Pachymetry 487 µm. Centered on the optic disc. Captured on a Topcon TRC-NW400 fundus camera. Intraocular pressure (IOP) 16 mmHg by non-contact tonometry
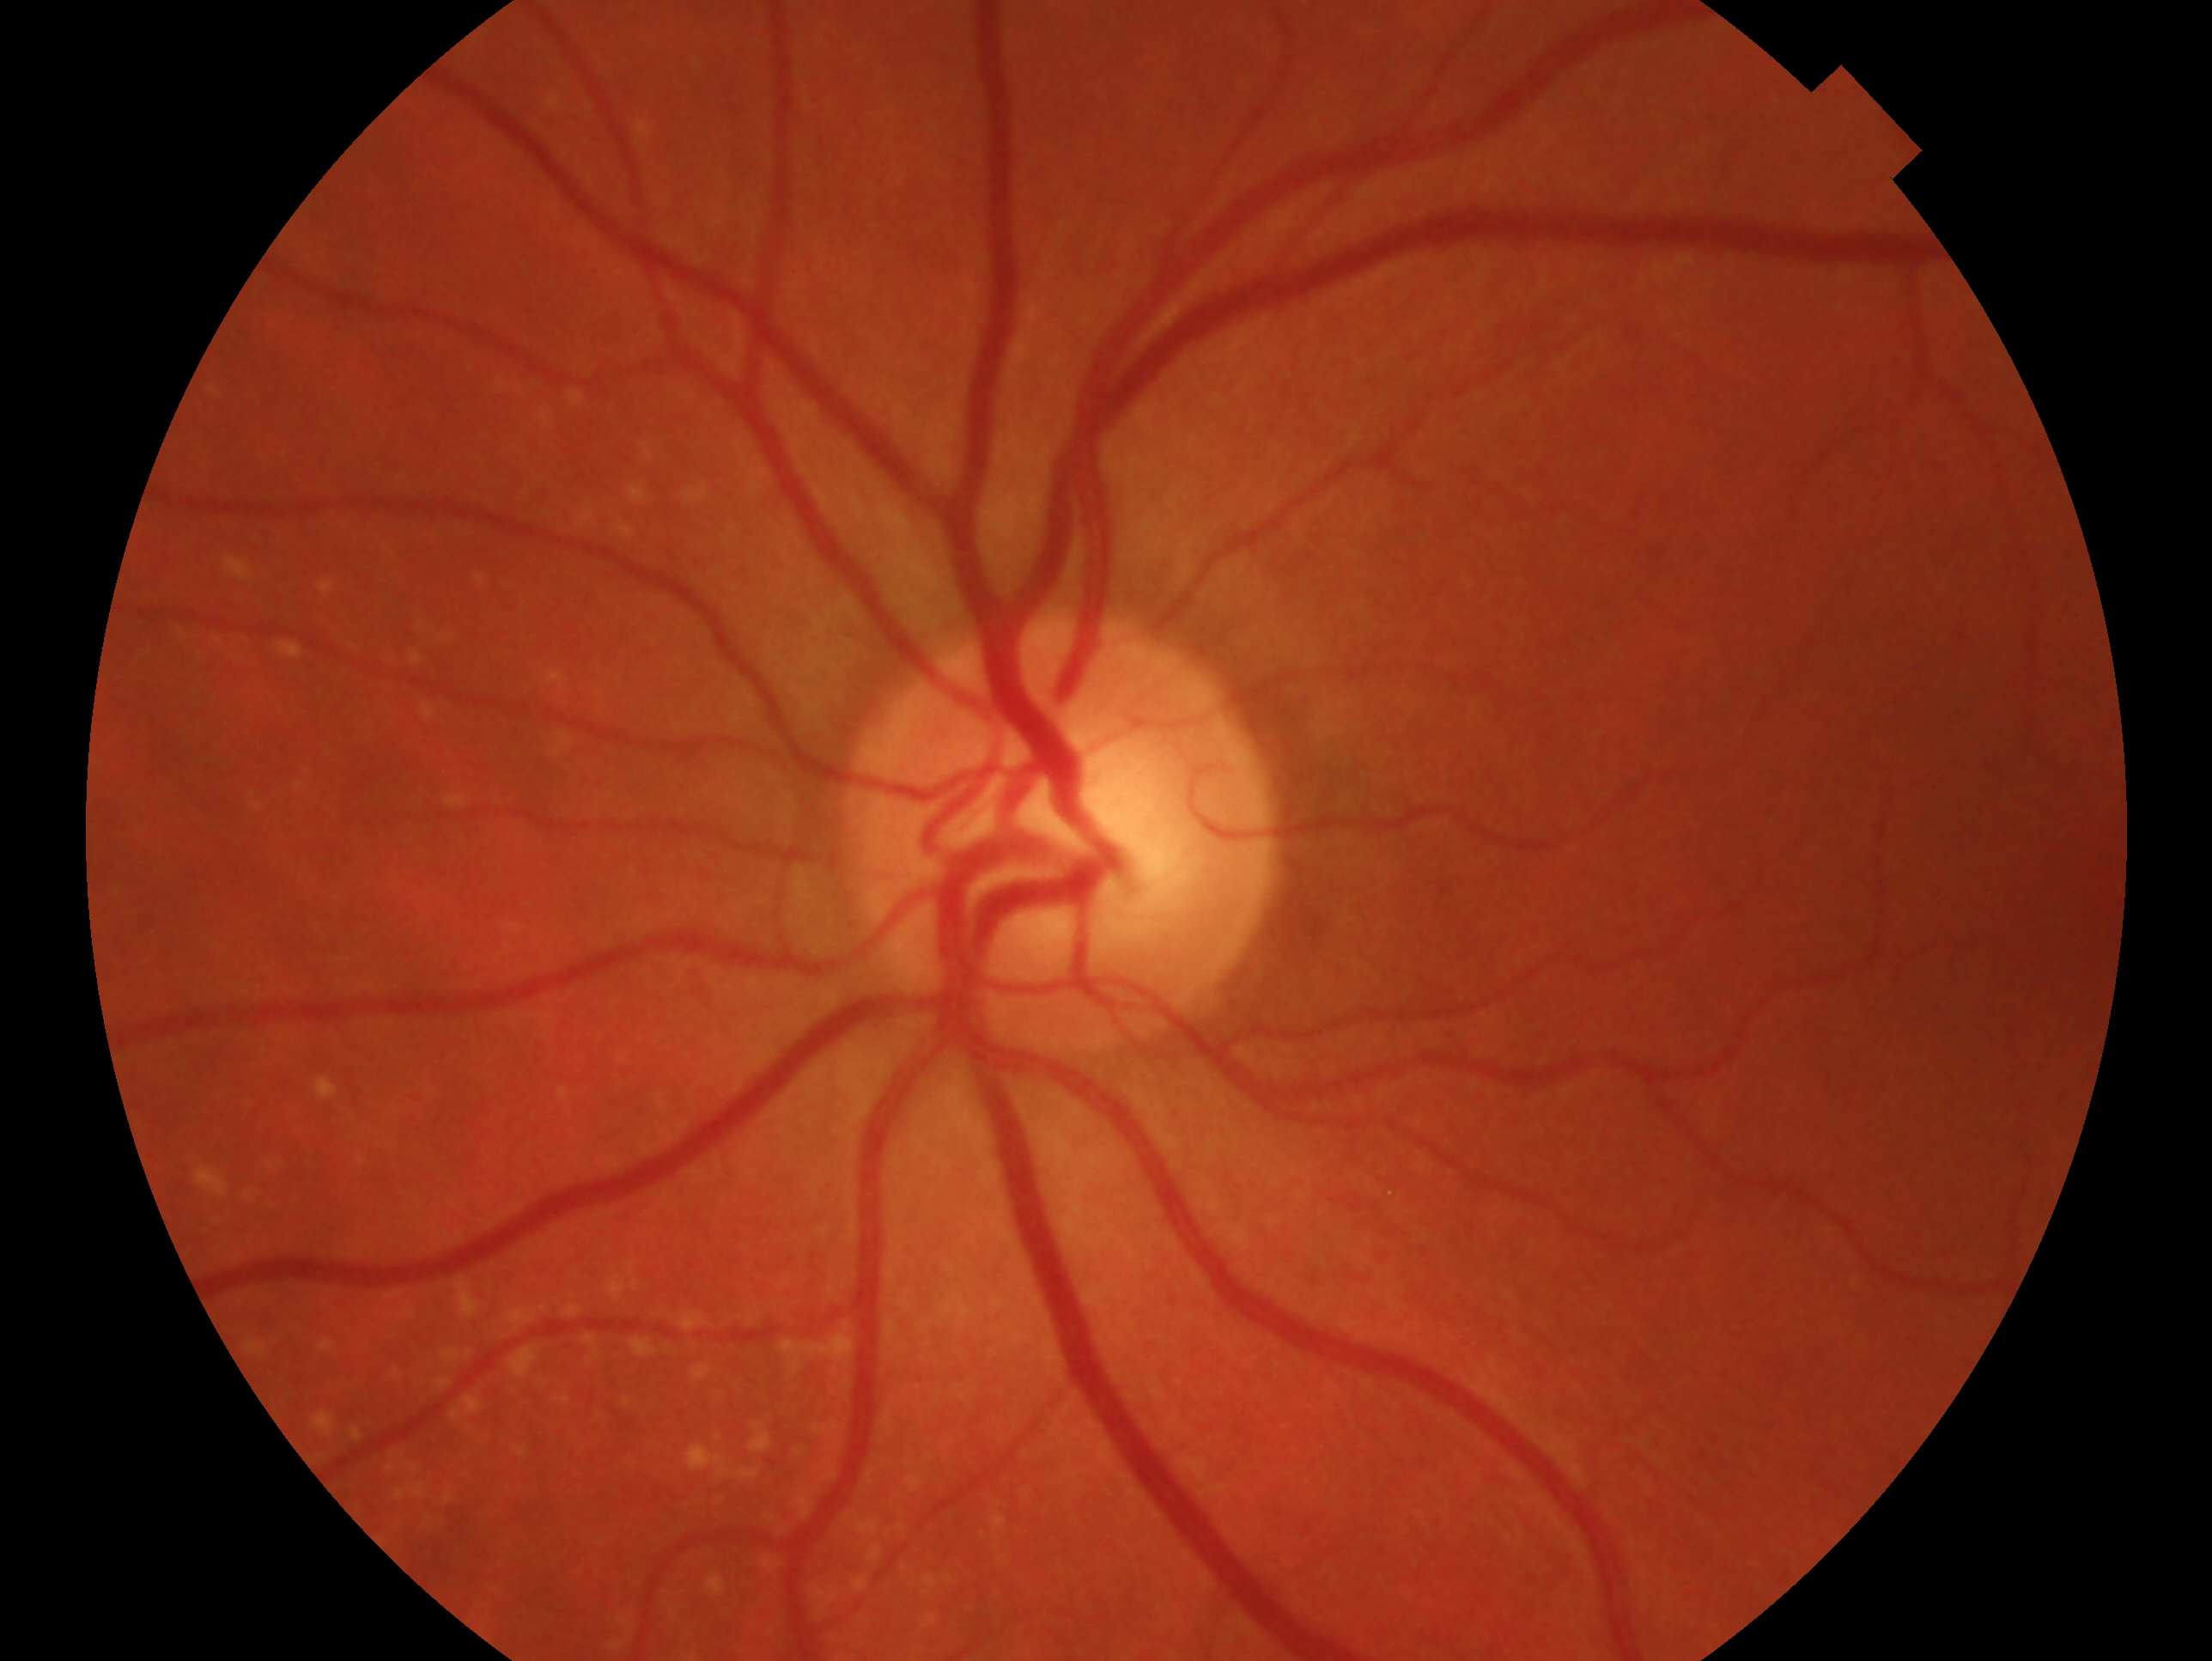
laterality=left
impression=no glaucoma